2352 by 1568 pixels · fundus photo.
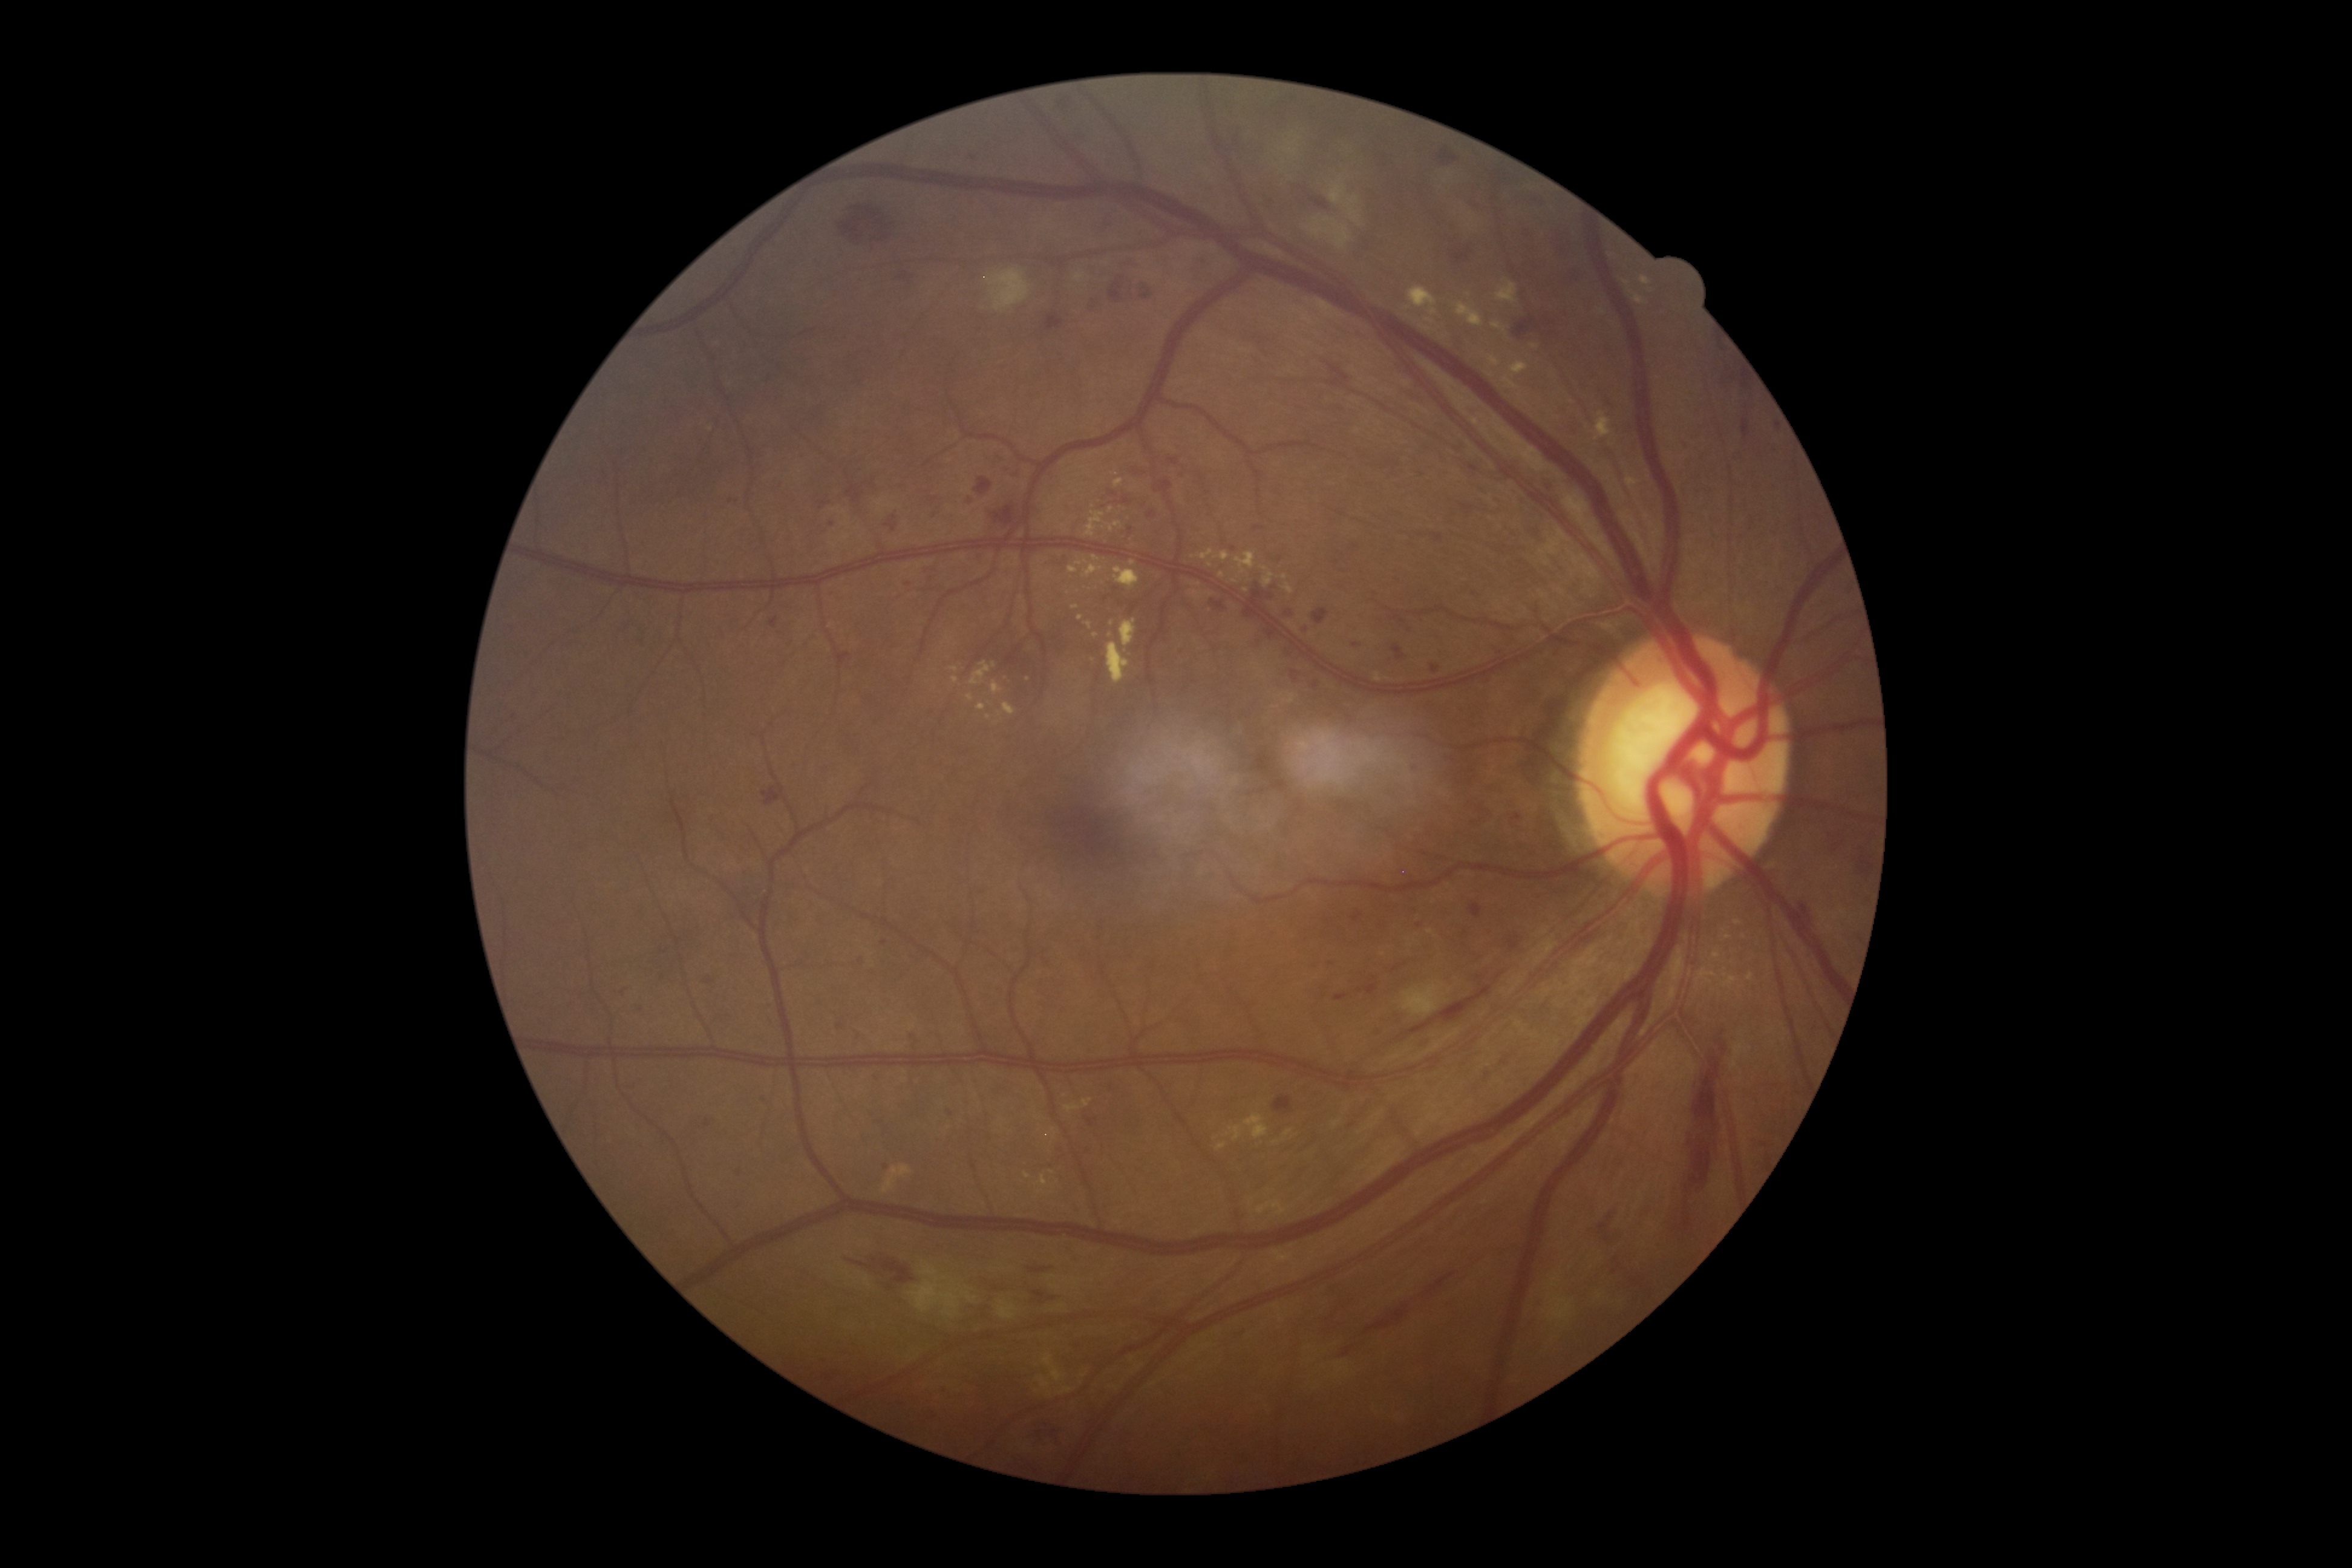 diabetic retinopathy grade: 3/4 — more than 20 intraretinal hemorrhages in each of 4 quadrants, definite venous beading in 2 or more quadrants, or prominent intraretinal microvascular abnormalities in 1 or more quadrants, with no signs of proliferative retinopathy.